Fundus photo; acquired with a Remidio Fundus on Phone (FOP) camera; 1659x2212px
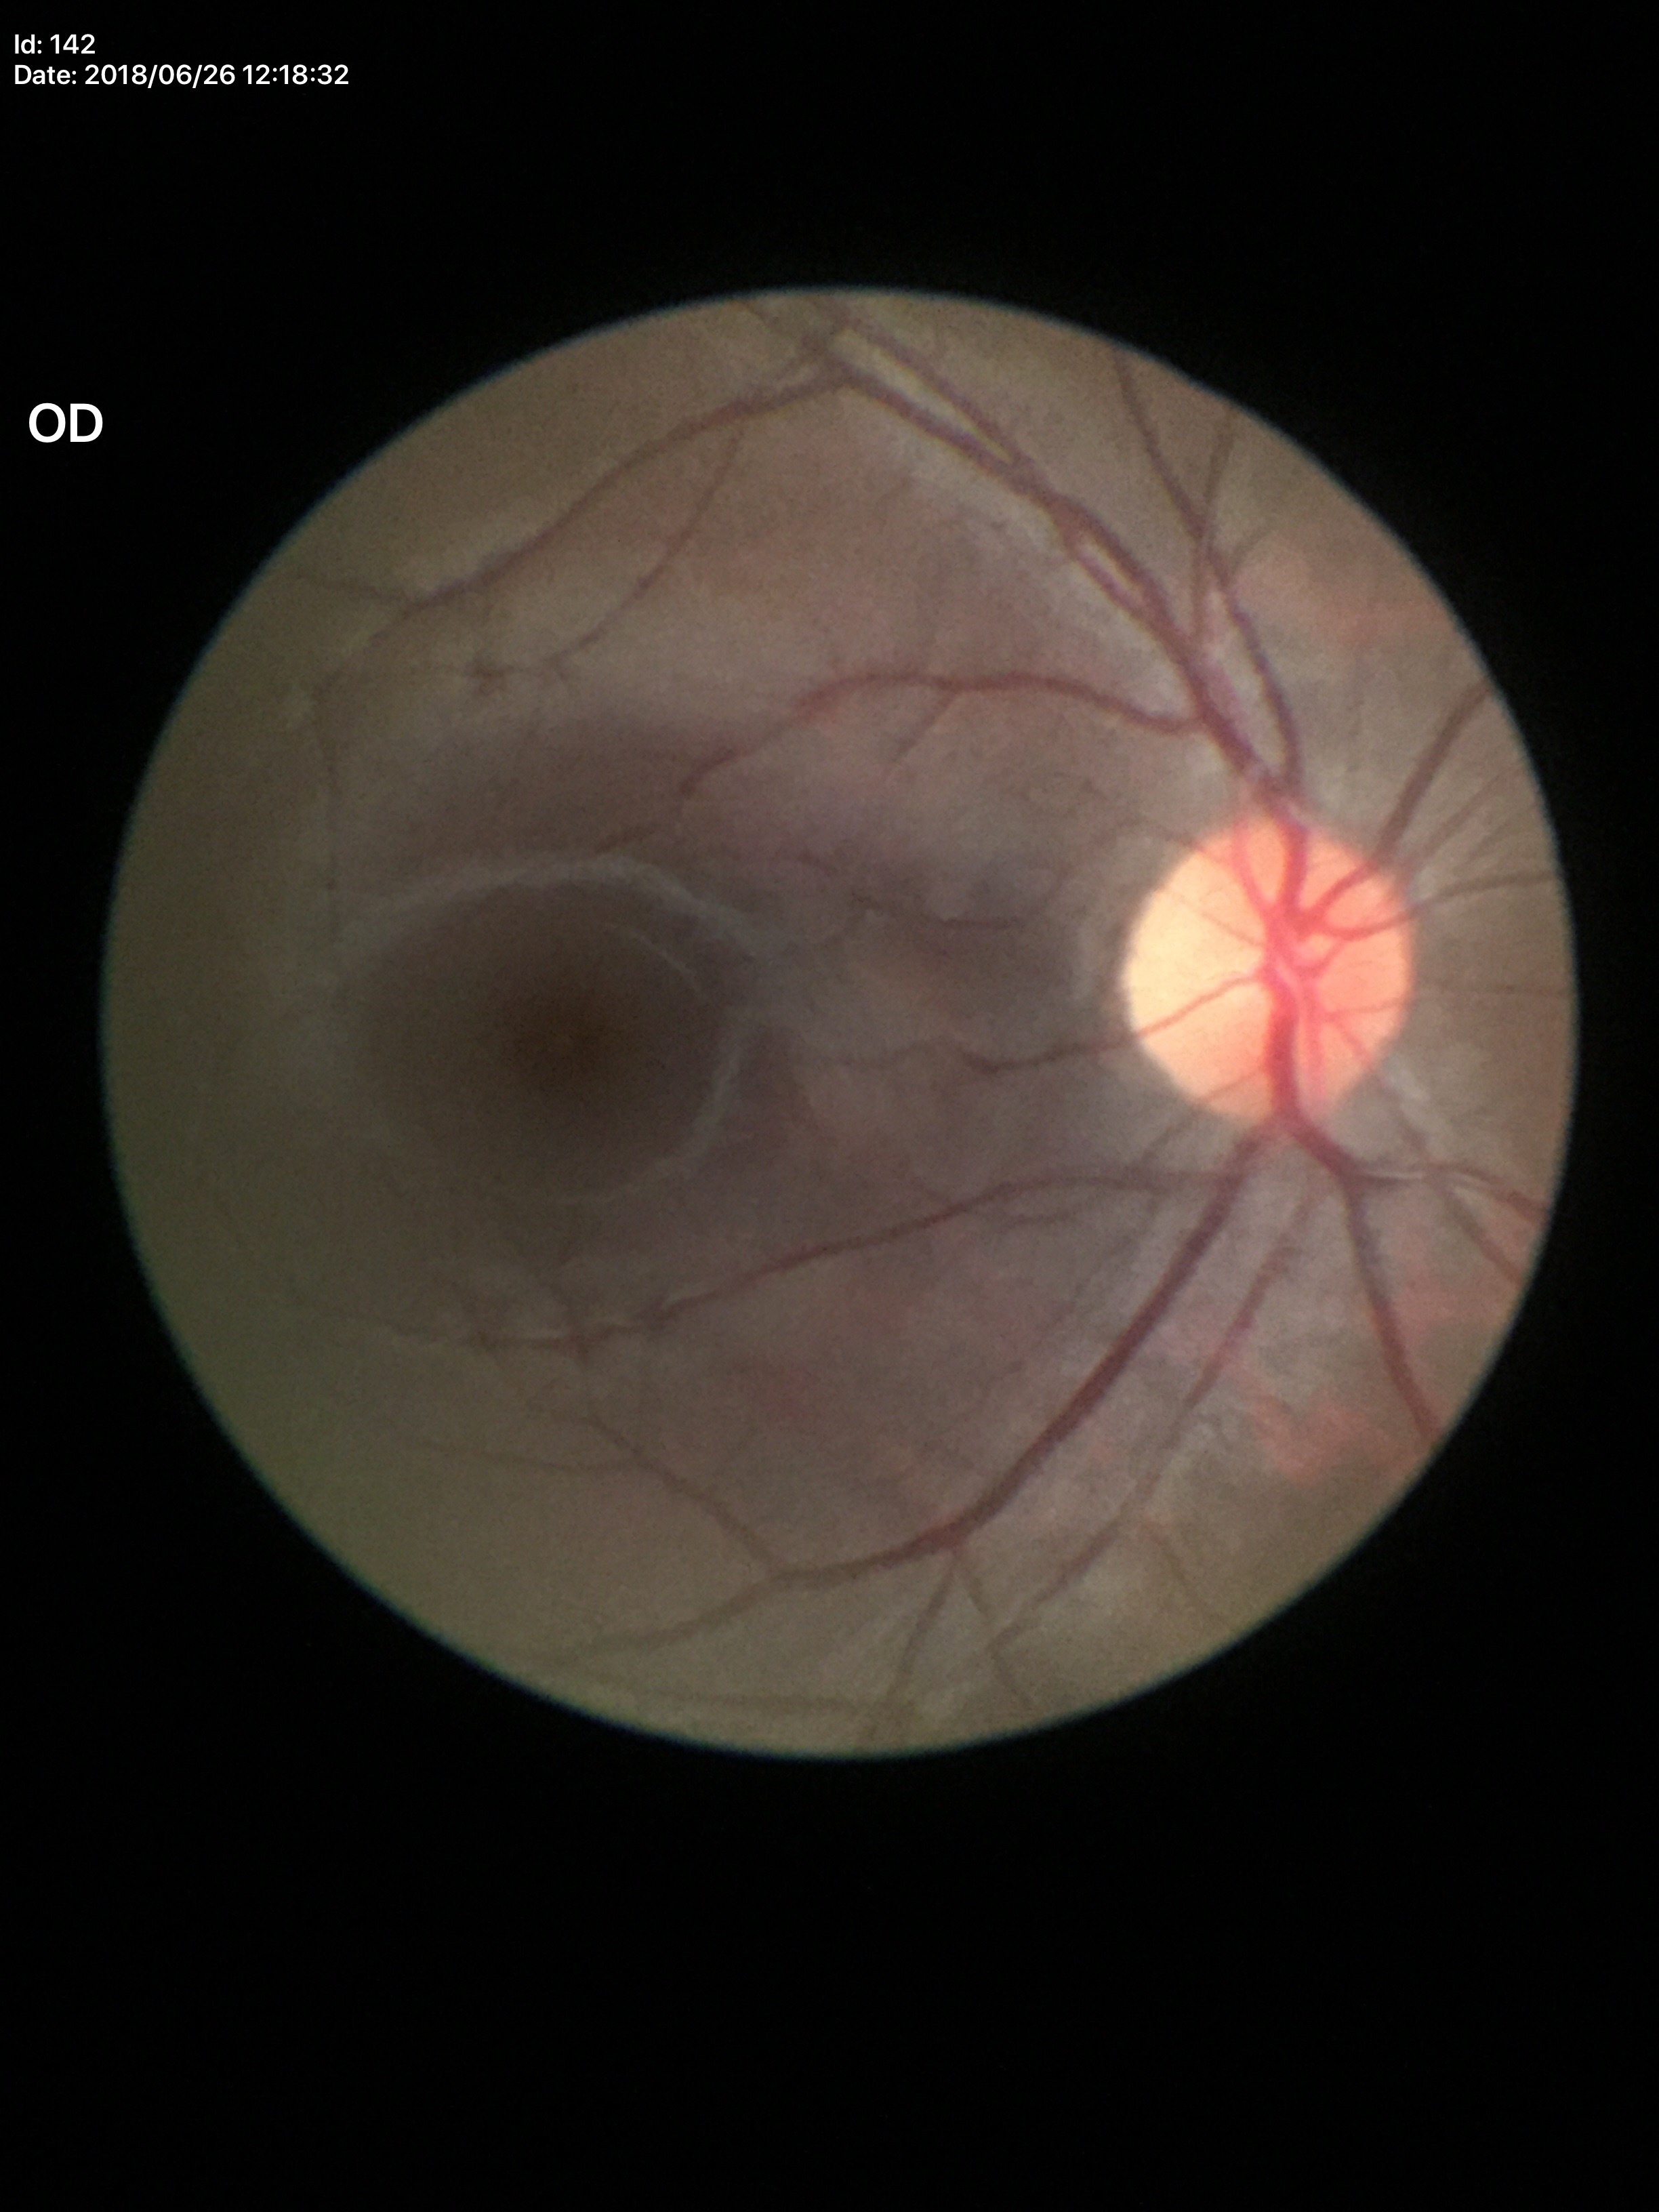 Glaucoma screening: negative; ACDR: 0.19; VCDR: 0.45.